Color fundus photograph — 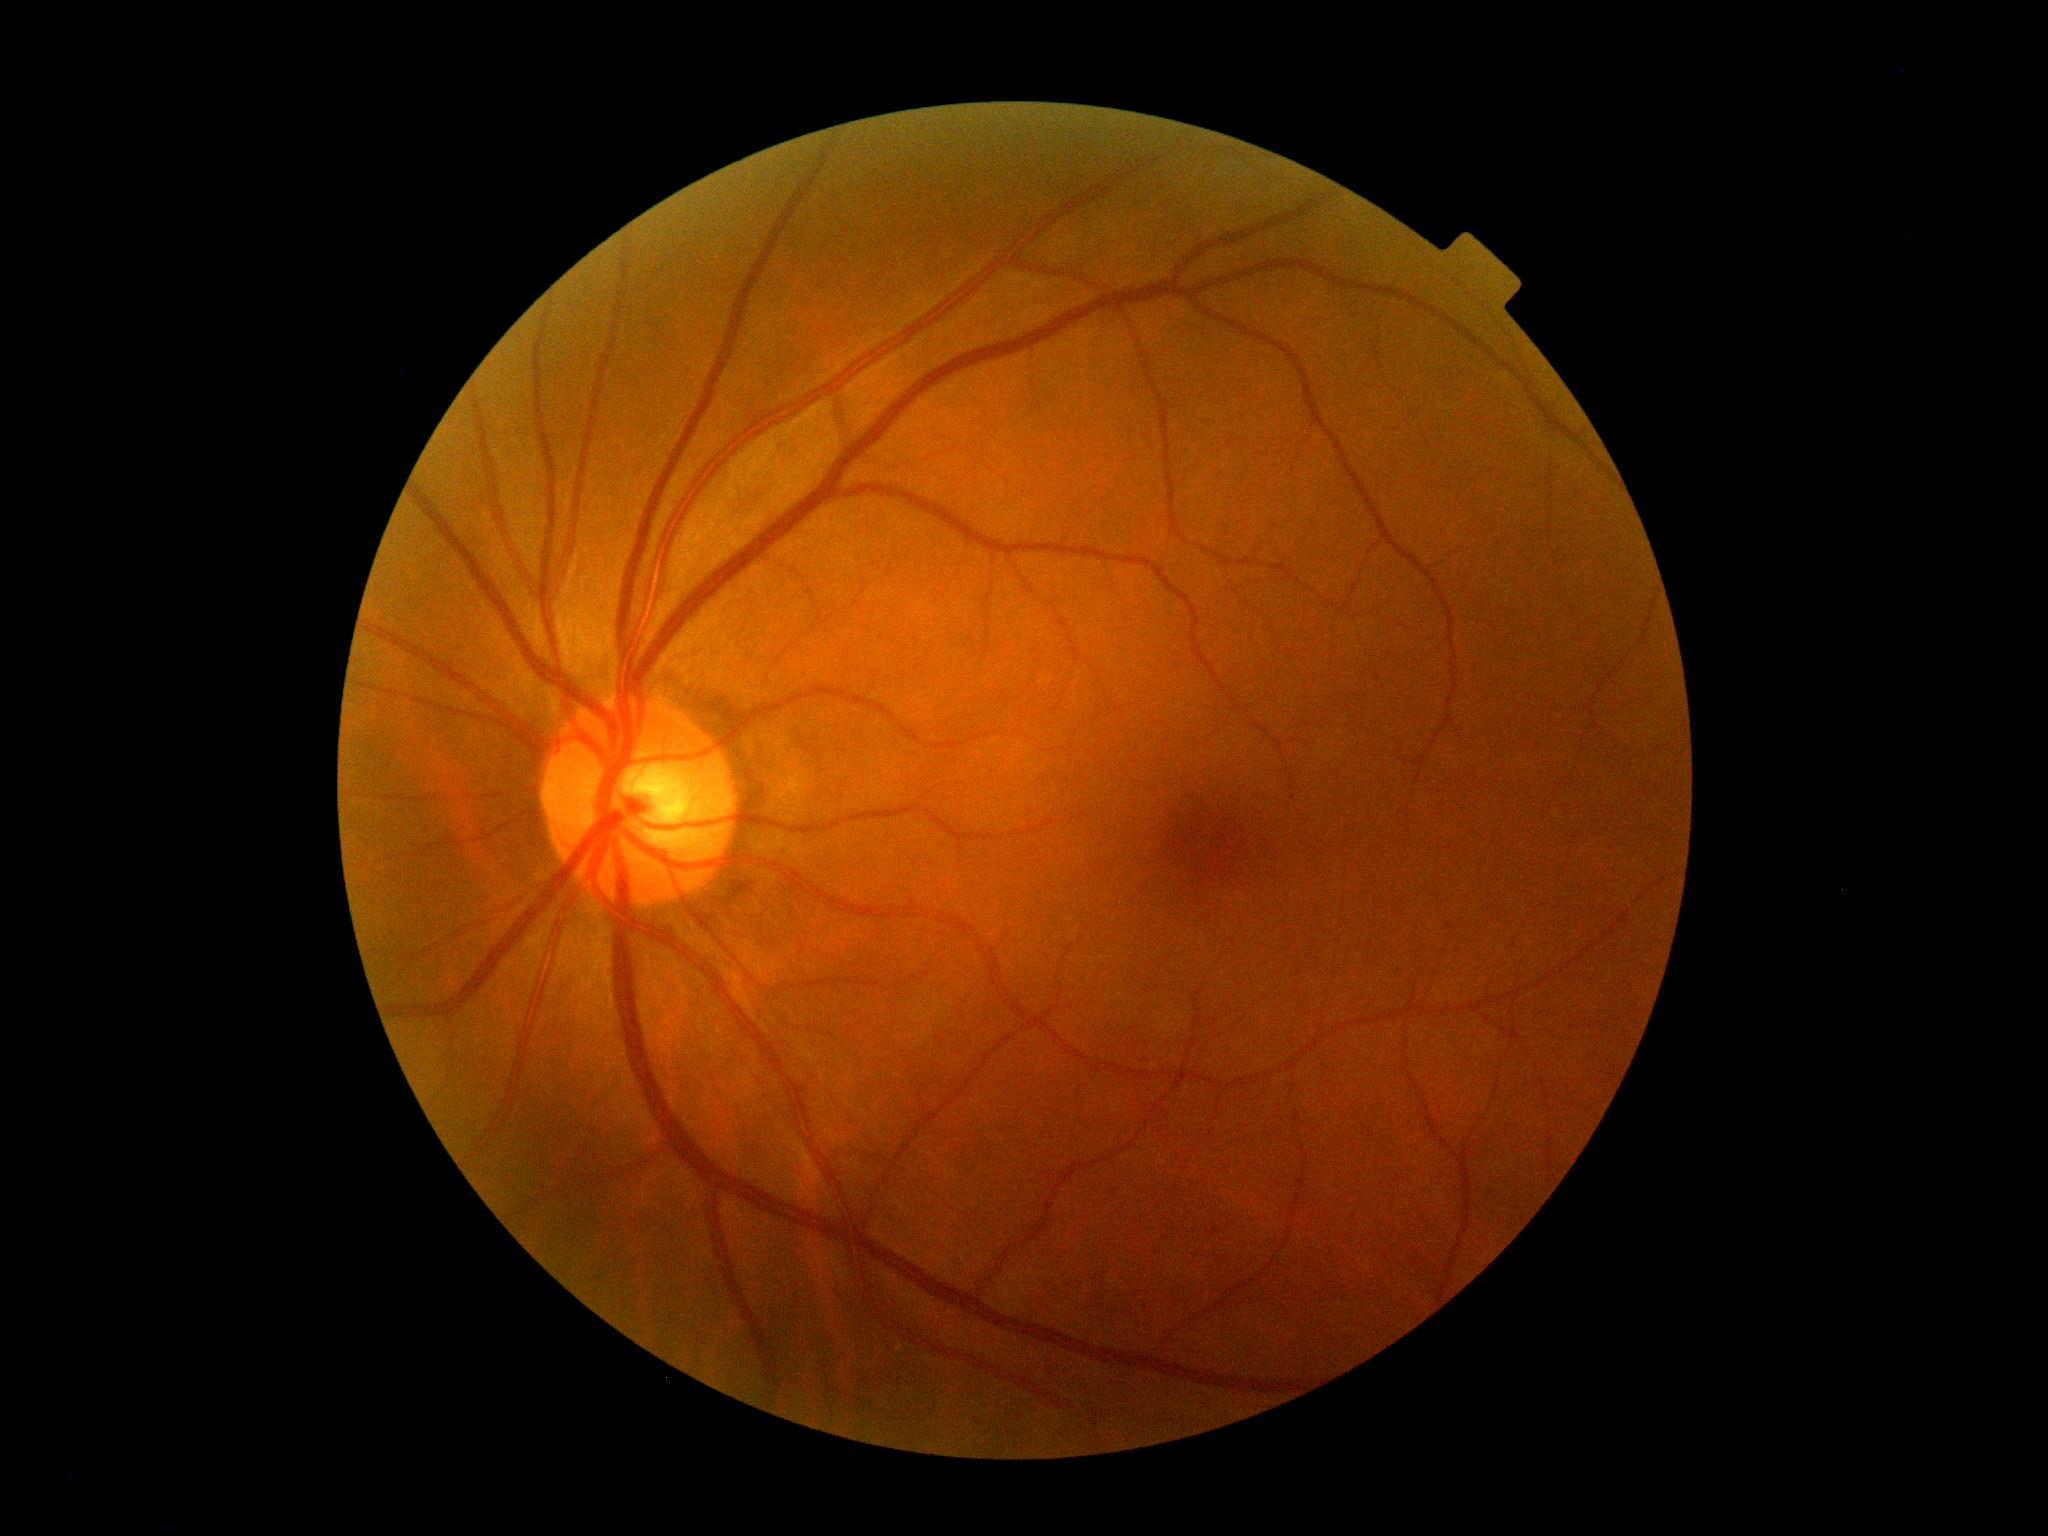

diabetic retinopathy = grade 0 (no apparent retinopathy)
DR impression = negative for DR